FOV: 50 degrees.
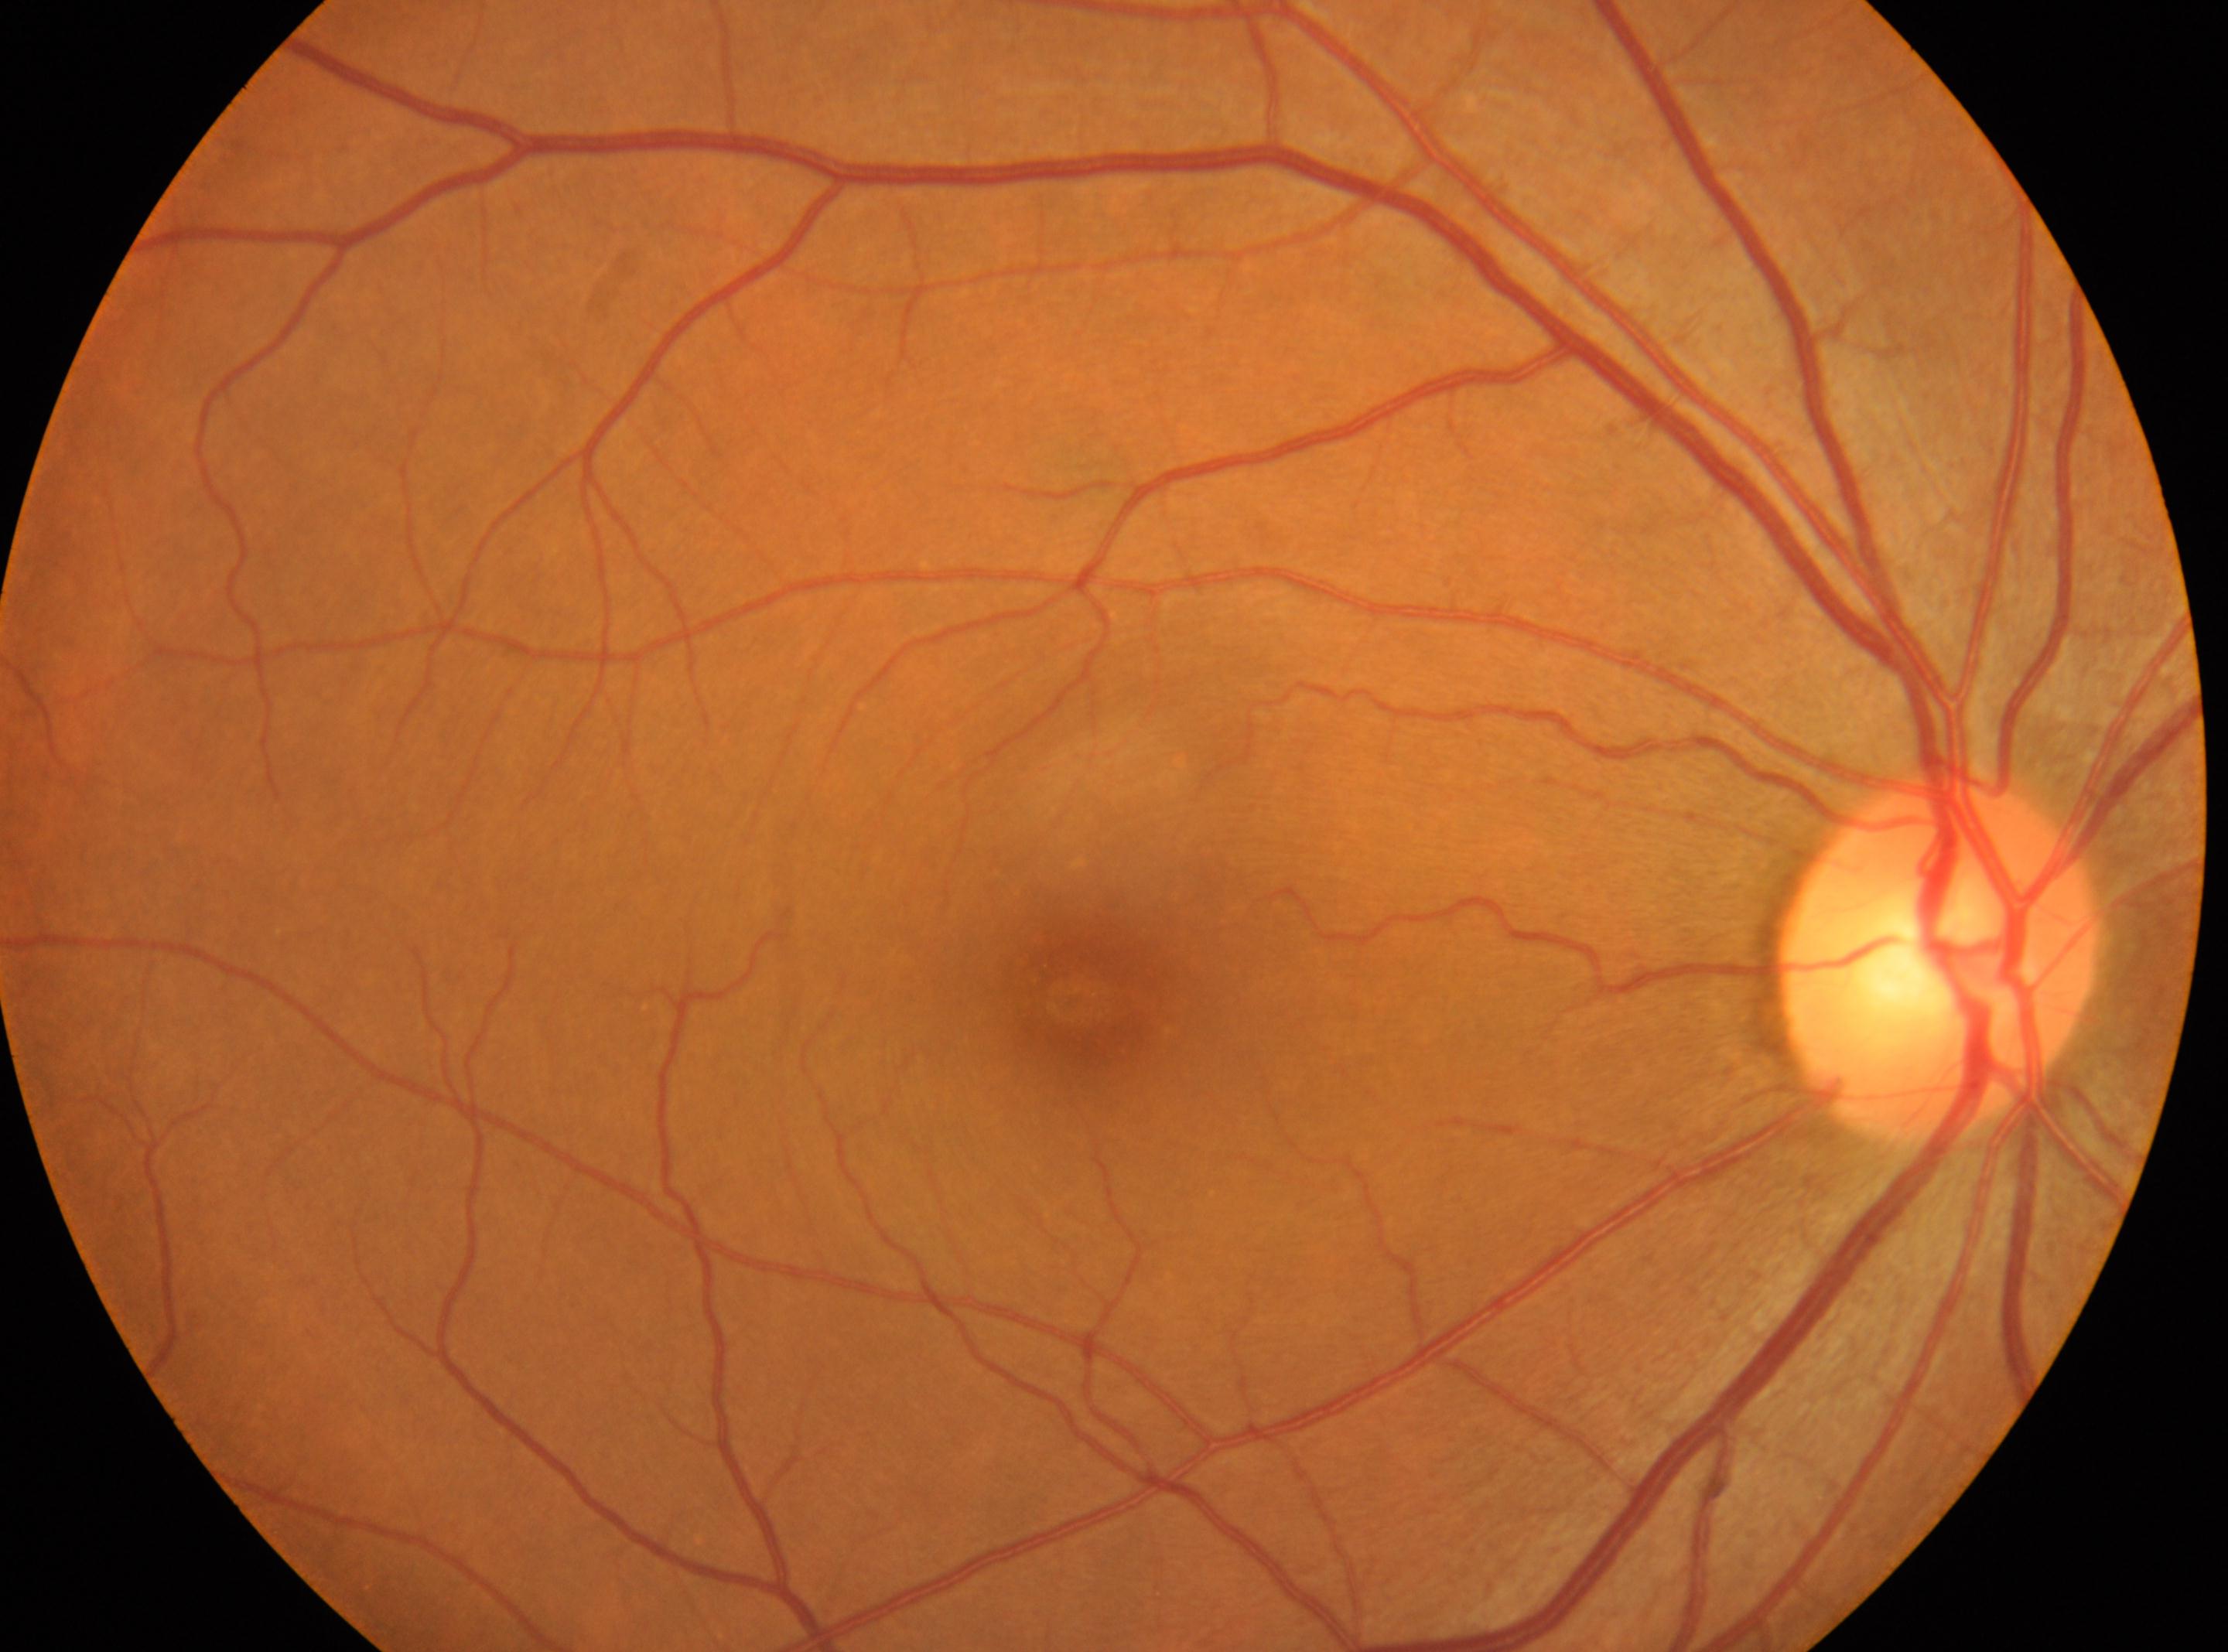 No diabetic retinopathy identified. Disc center: [1935, 957]. Macula center: [1072, 999]. Retinopathy grade is 0. This is the oculus dexter.